Color fundus image, 2352x1568 — 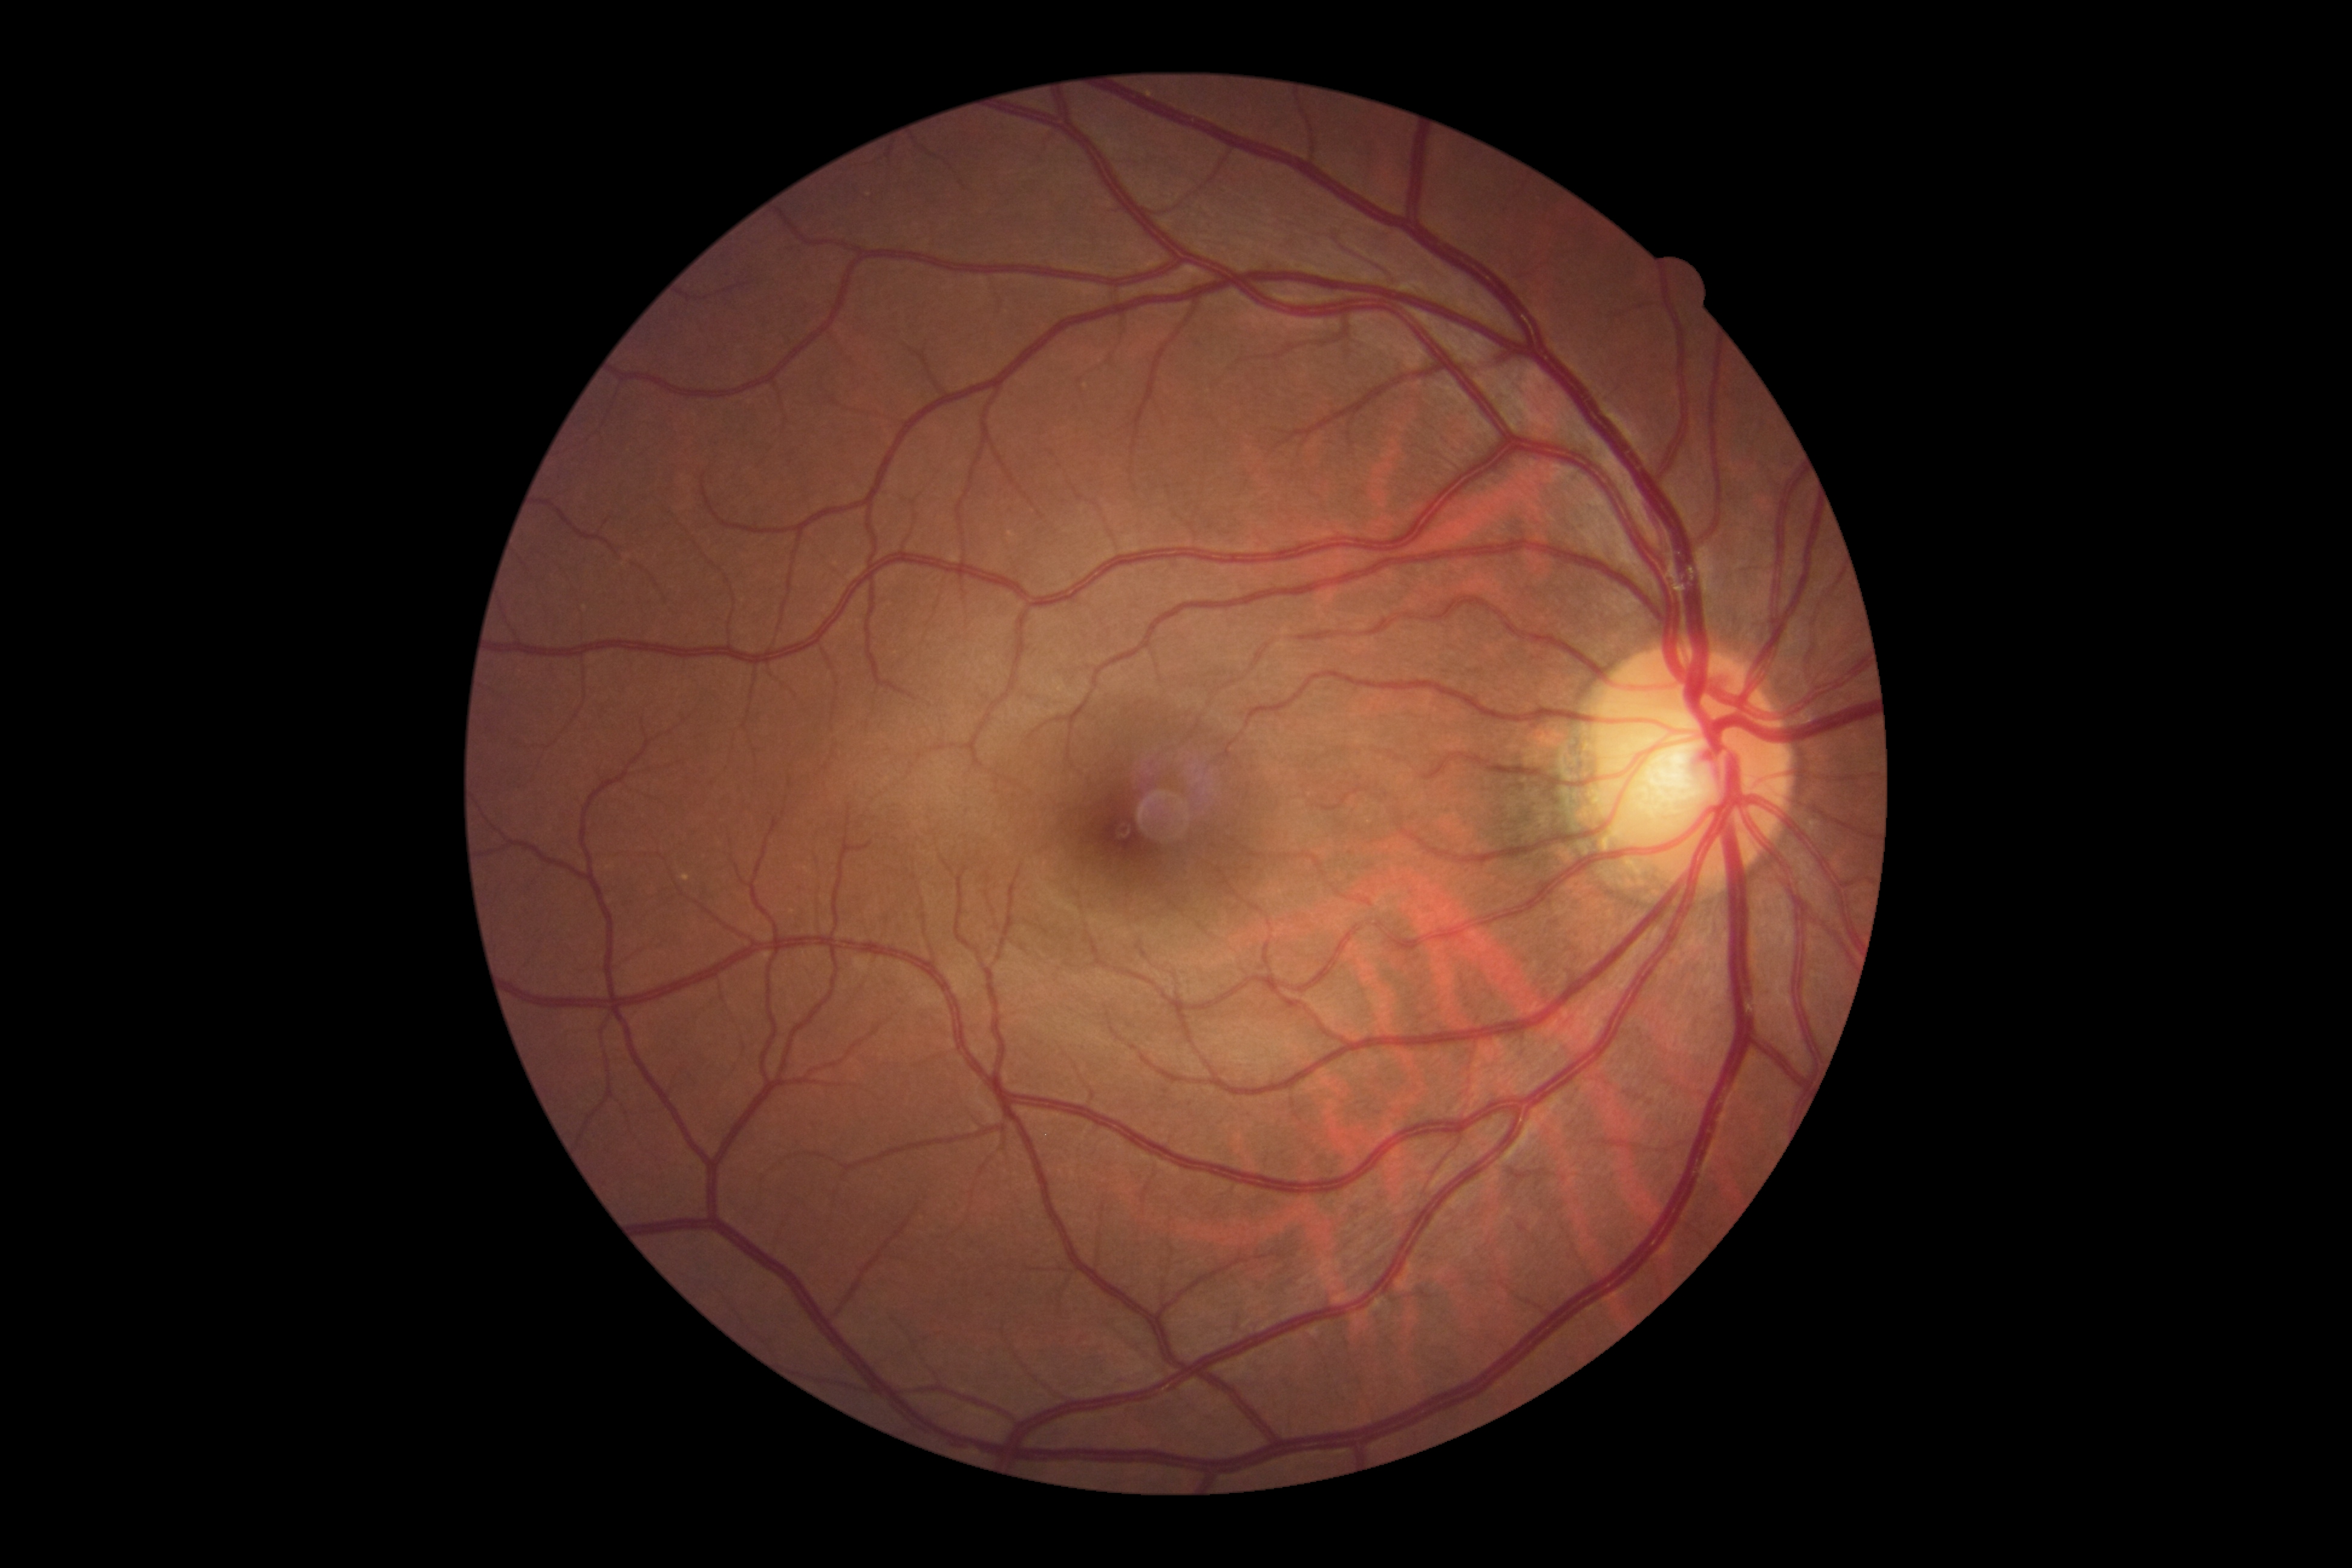 diabetic retinopathy grade: no apparent retinopathy (0).